45-degree field of view, camera: NIDEK AFC-230
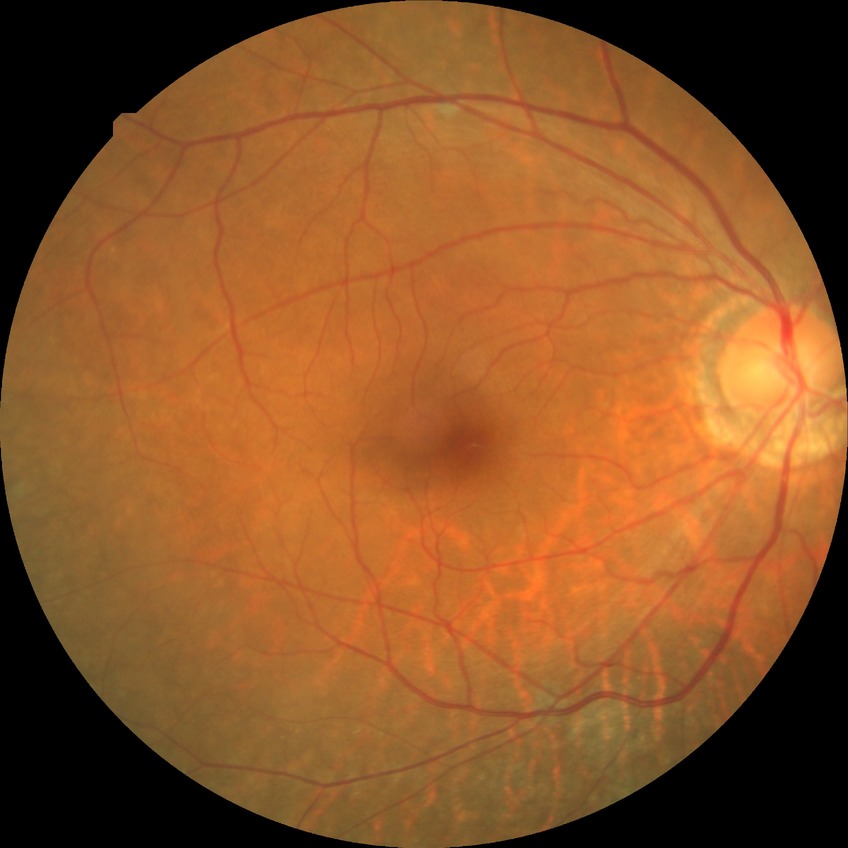 Diabetic retinopathy stage is no diabetic retinopathy.